2048 x 1536 pixels; 45° FOV:
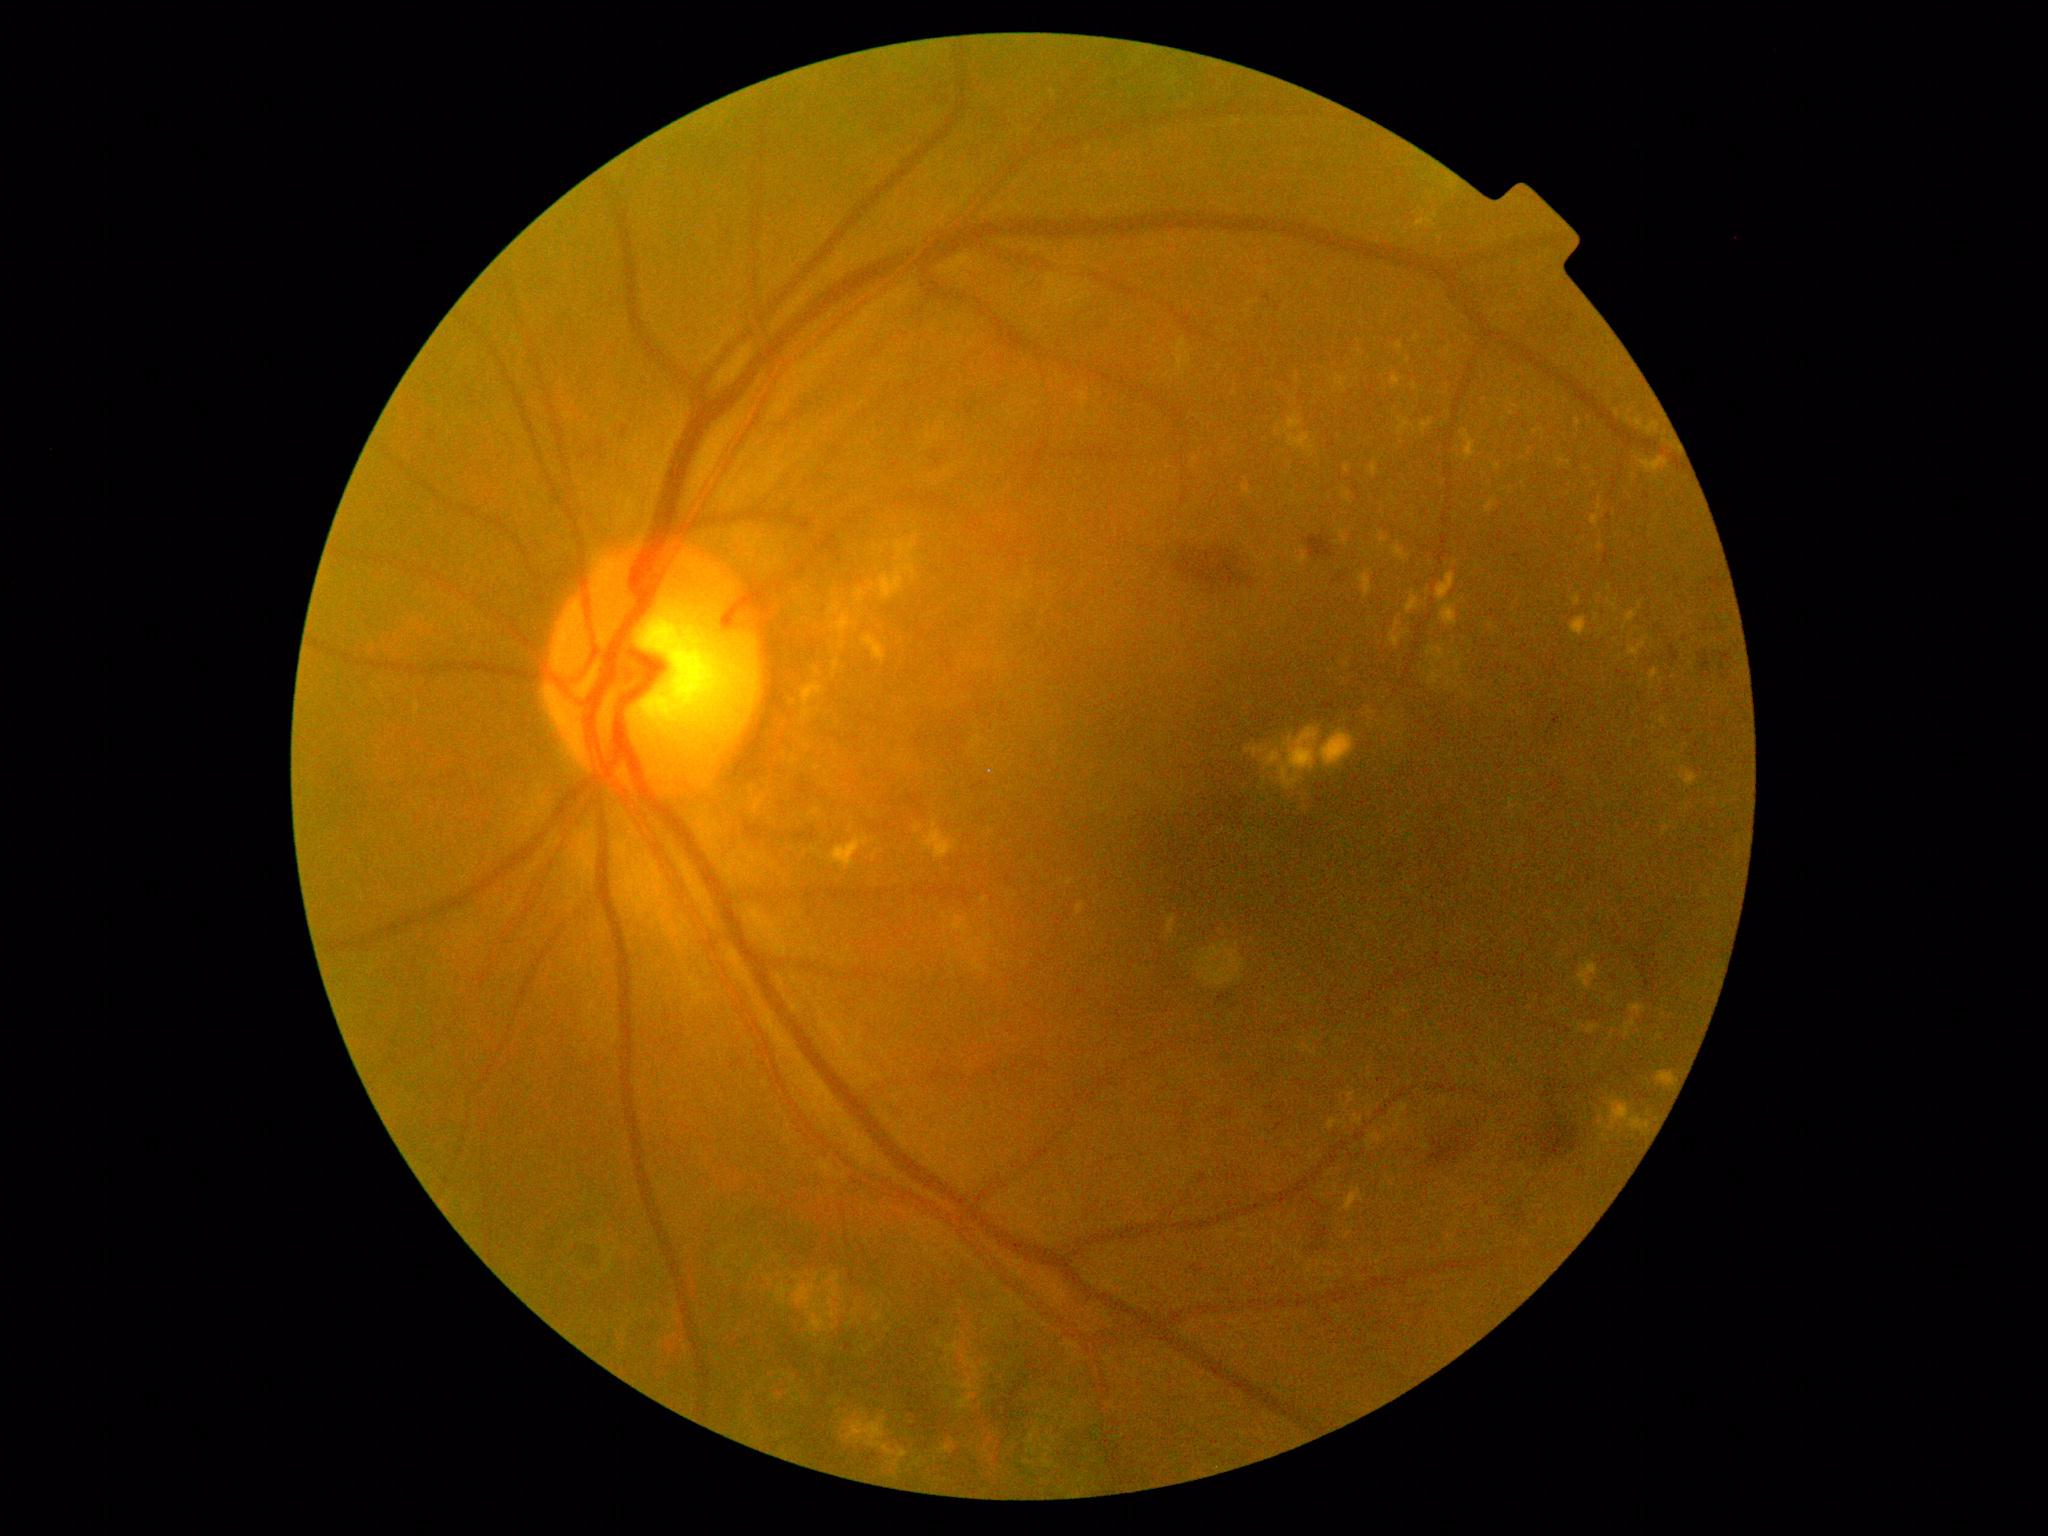 DR stage: 2/4
Lesions identified (partial list):
* SEs: none
* EXs (subset): 1390/620/1410/649 | 1261/726/1355/793 | 1293/788/1308/818 | 1493/464/1502/471 | 1631/1004/1646/1015 | 830/610/854/650 | 1598/498/1605/514 | 1327/1118/1347/1130 | 1427/647/1446/663 | 1348/1092/1355/1104 | 1343/491/1353/504 | 1398/418/1411/435 | 831/659/841/677 | 1570/617/1589/637
* Small EXs approximately at point(1512, 414) | point(1531, 1008) | point(1417, 337) | point(819, 711) | point(1515, 406)
* MAs: none
* HEs (subset): 1245/1073/1268/1093 | 1553/716/1562/726 | 1536/1123/1579/1161 | 1310/1196/1335/1249 | 1514/554/1522/560 | 1323/699/1340/710 | 1304/531/1334/559 | 1173/546/1241/591 | 1191/1264/1204/1274
* Small HEs approximately at point(1284, 1107) | point(1686, 640) | point(1267, 298)